Davis DR grading · camera: NIDEK AFC-230 · 848x848px.
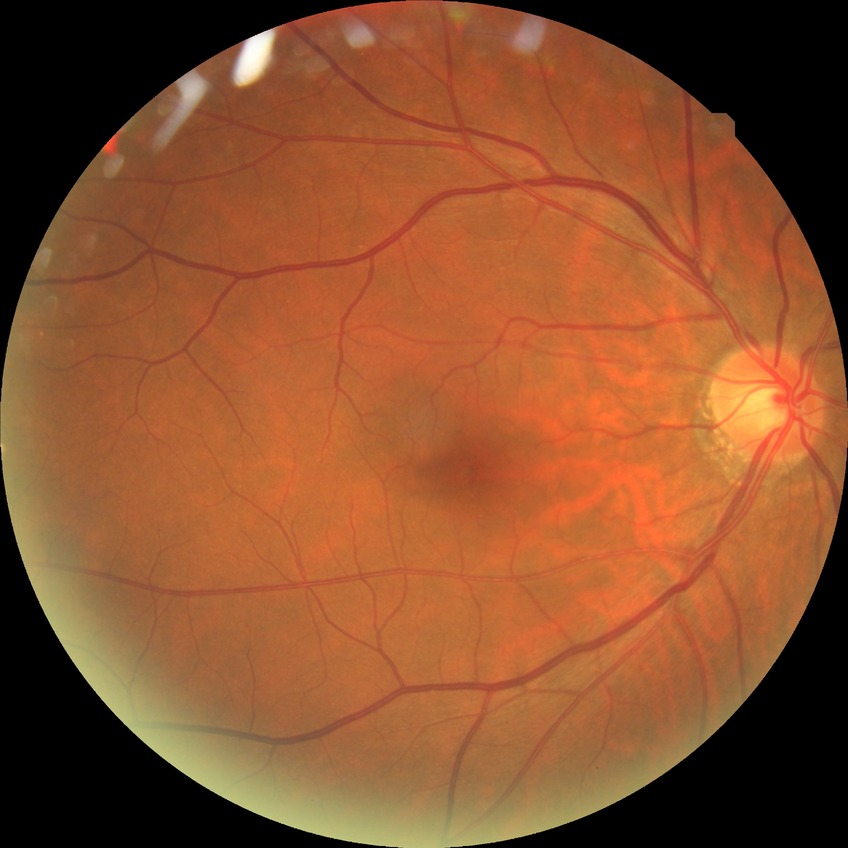

Retinopathy grade: no diabetic retinopathy.